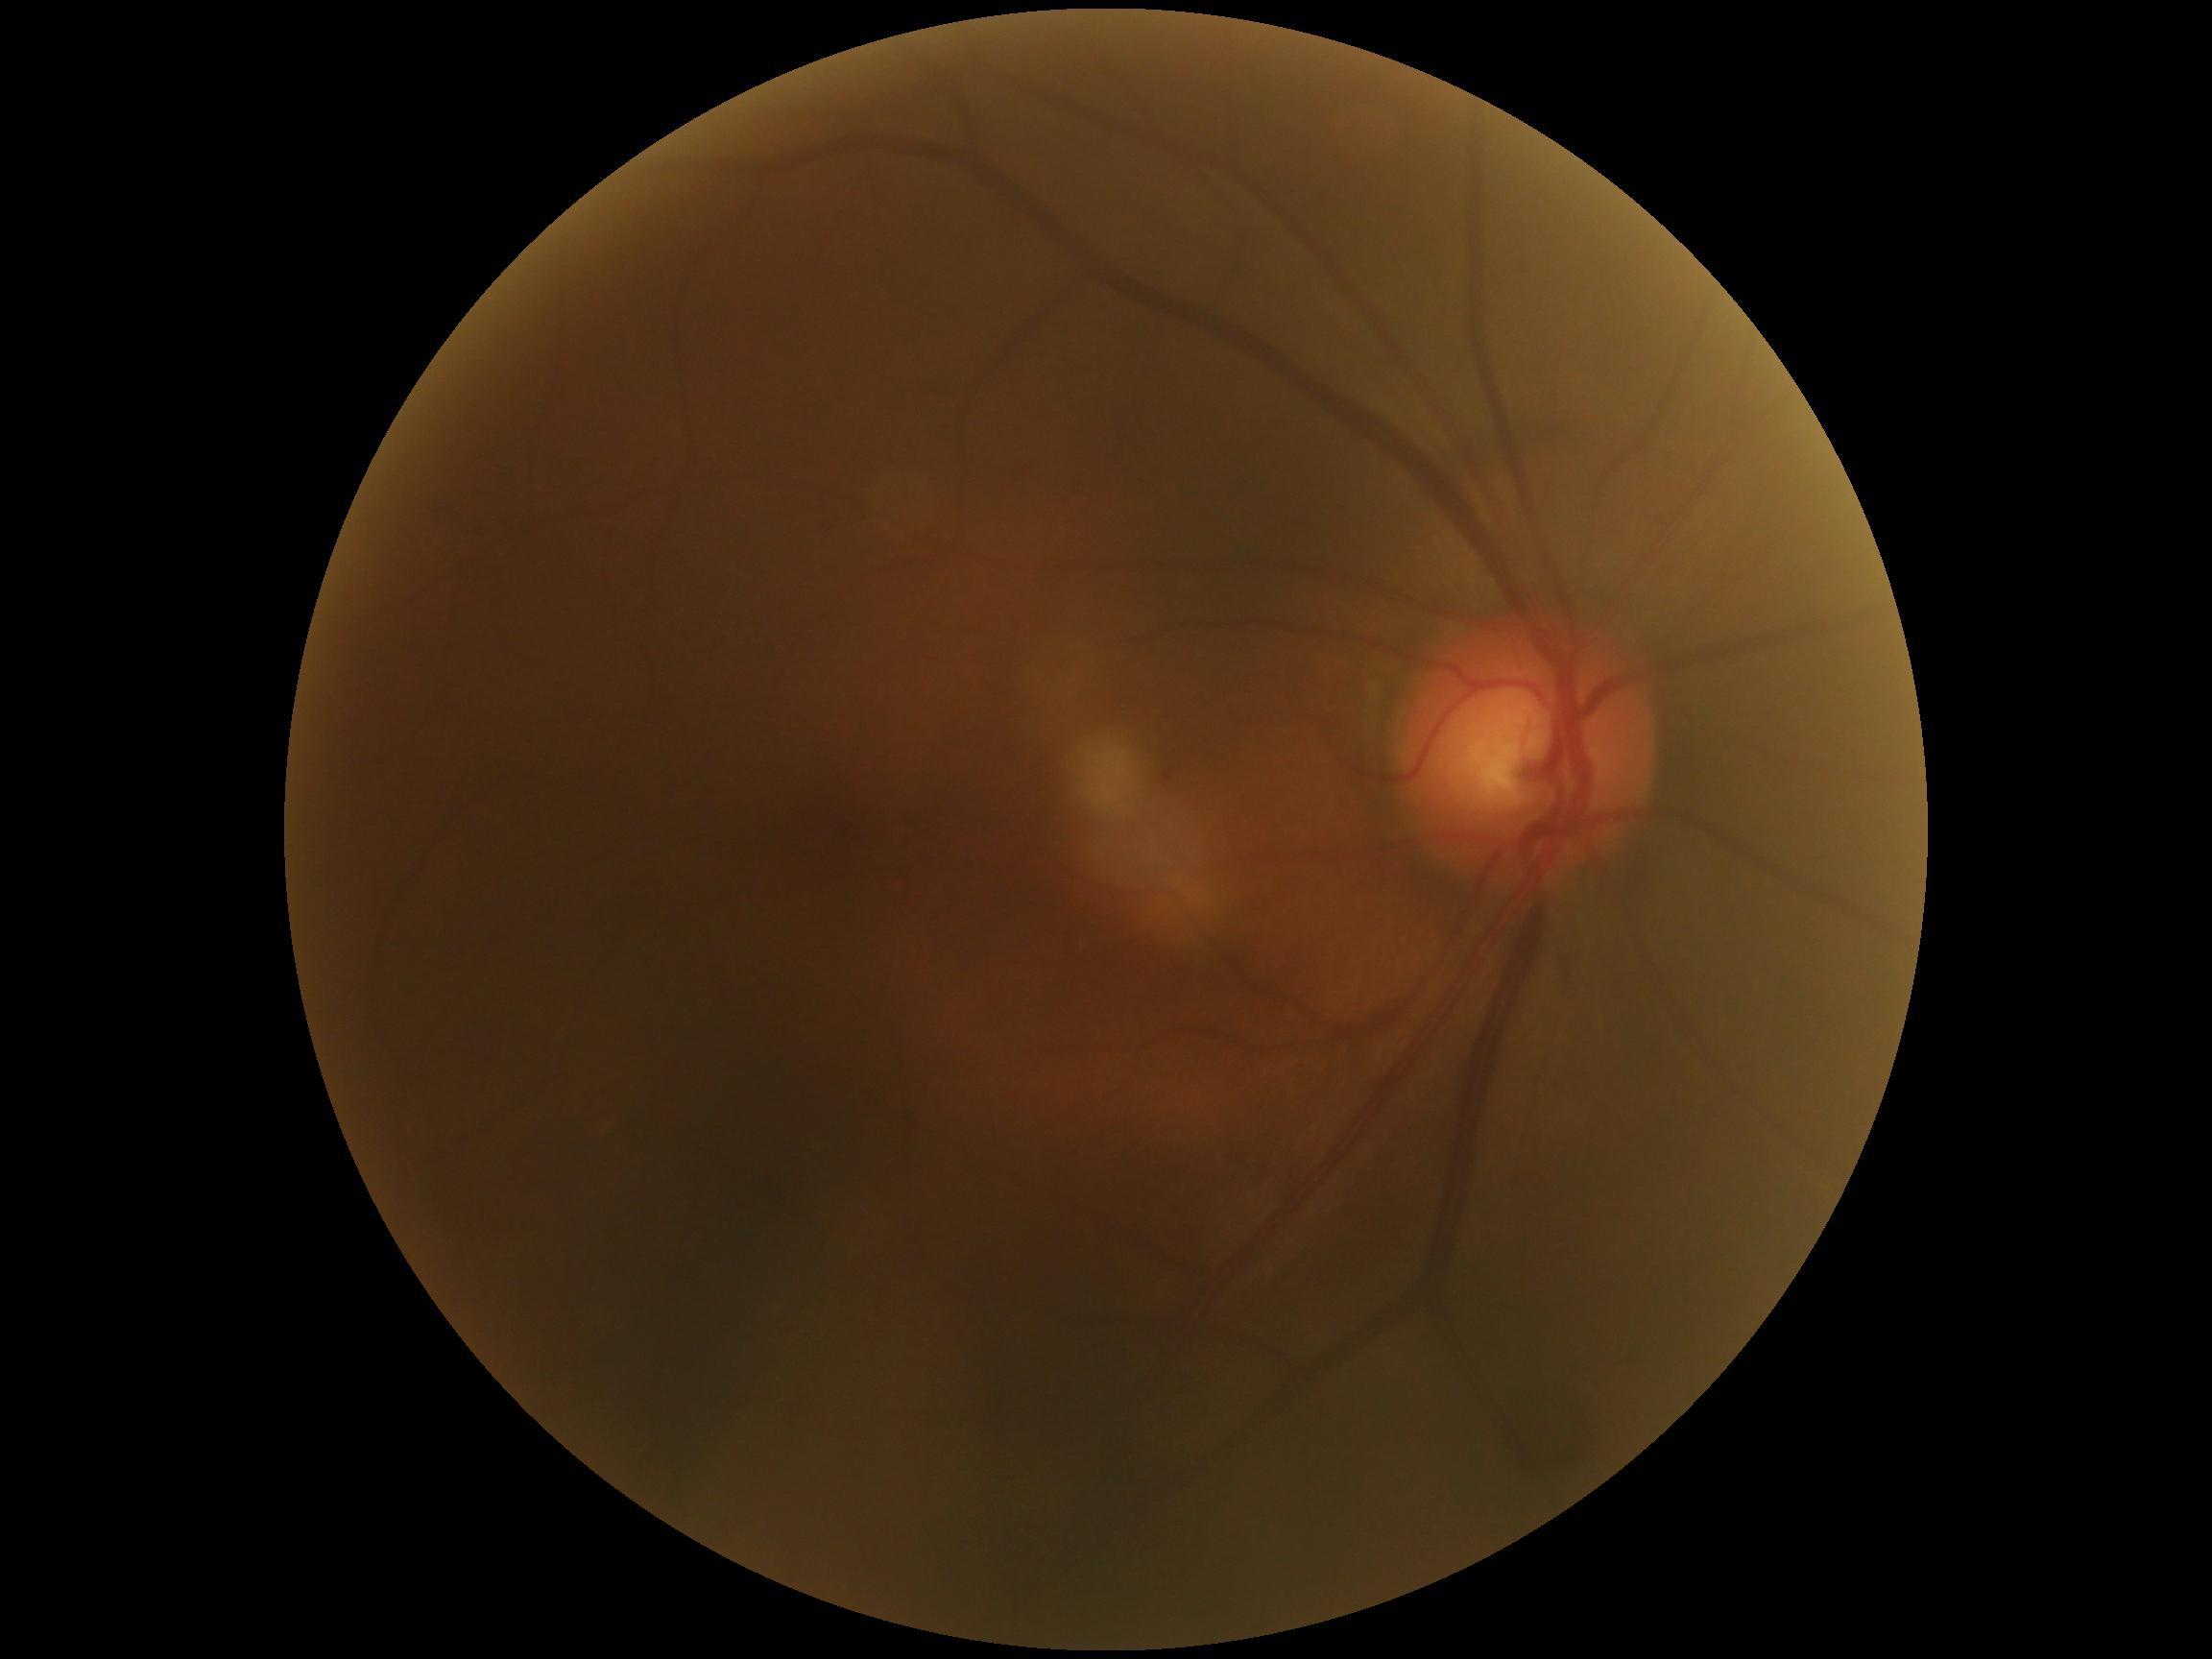
- retinopathy grade — 0